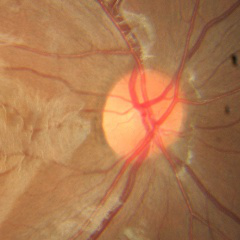 No signs of glaucoma.